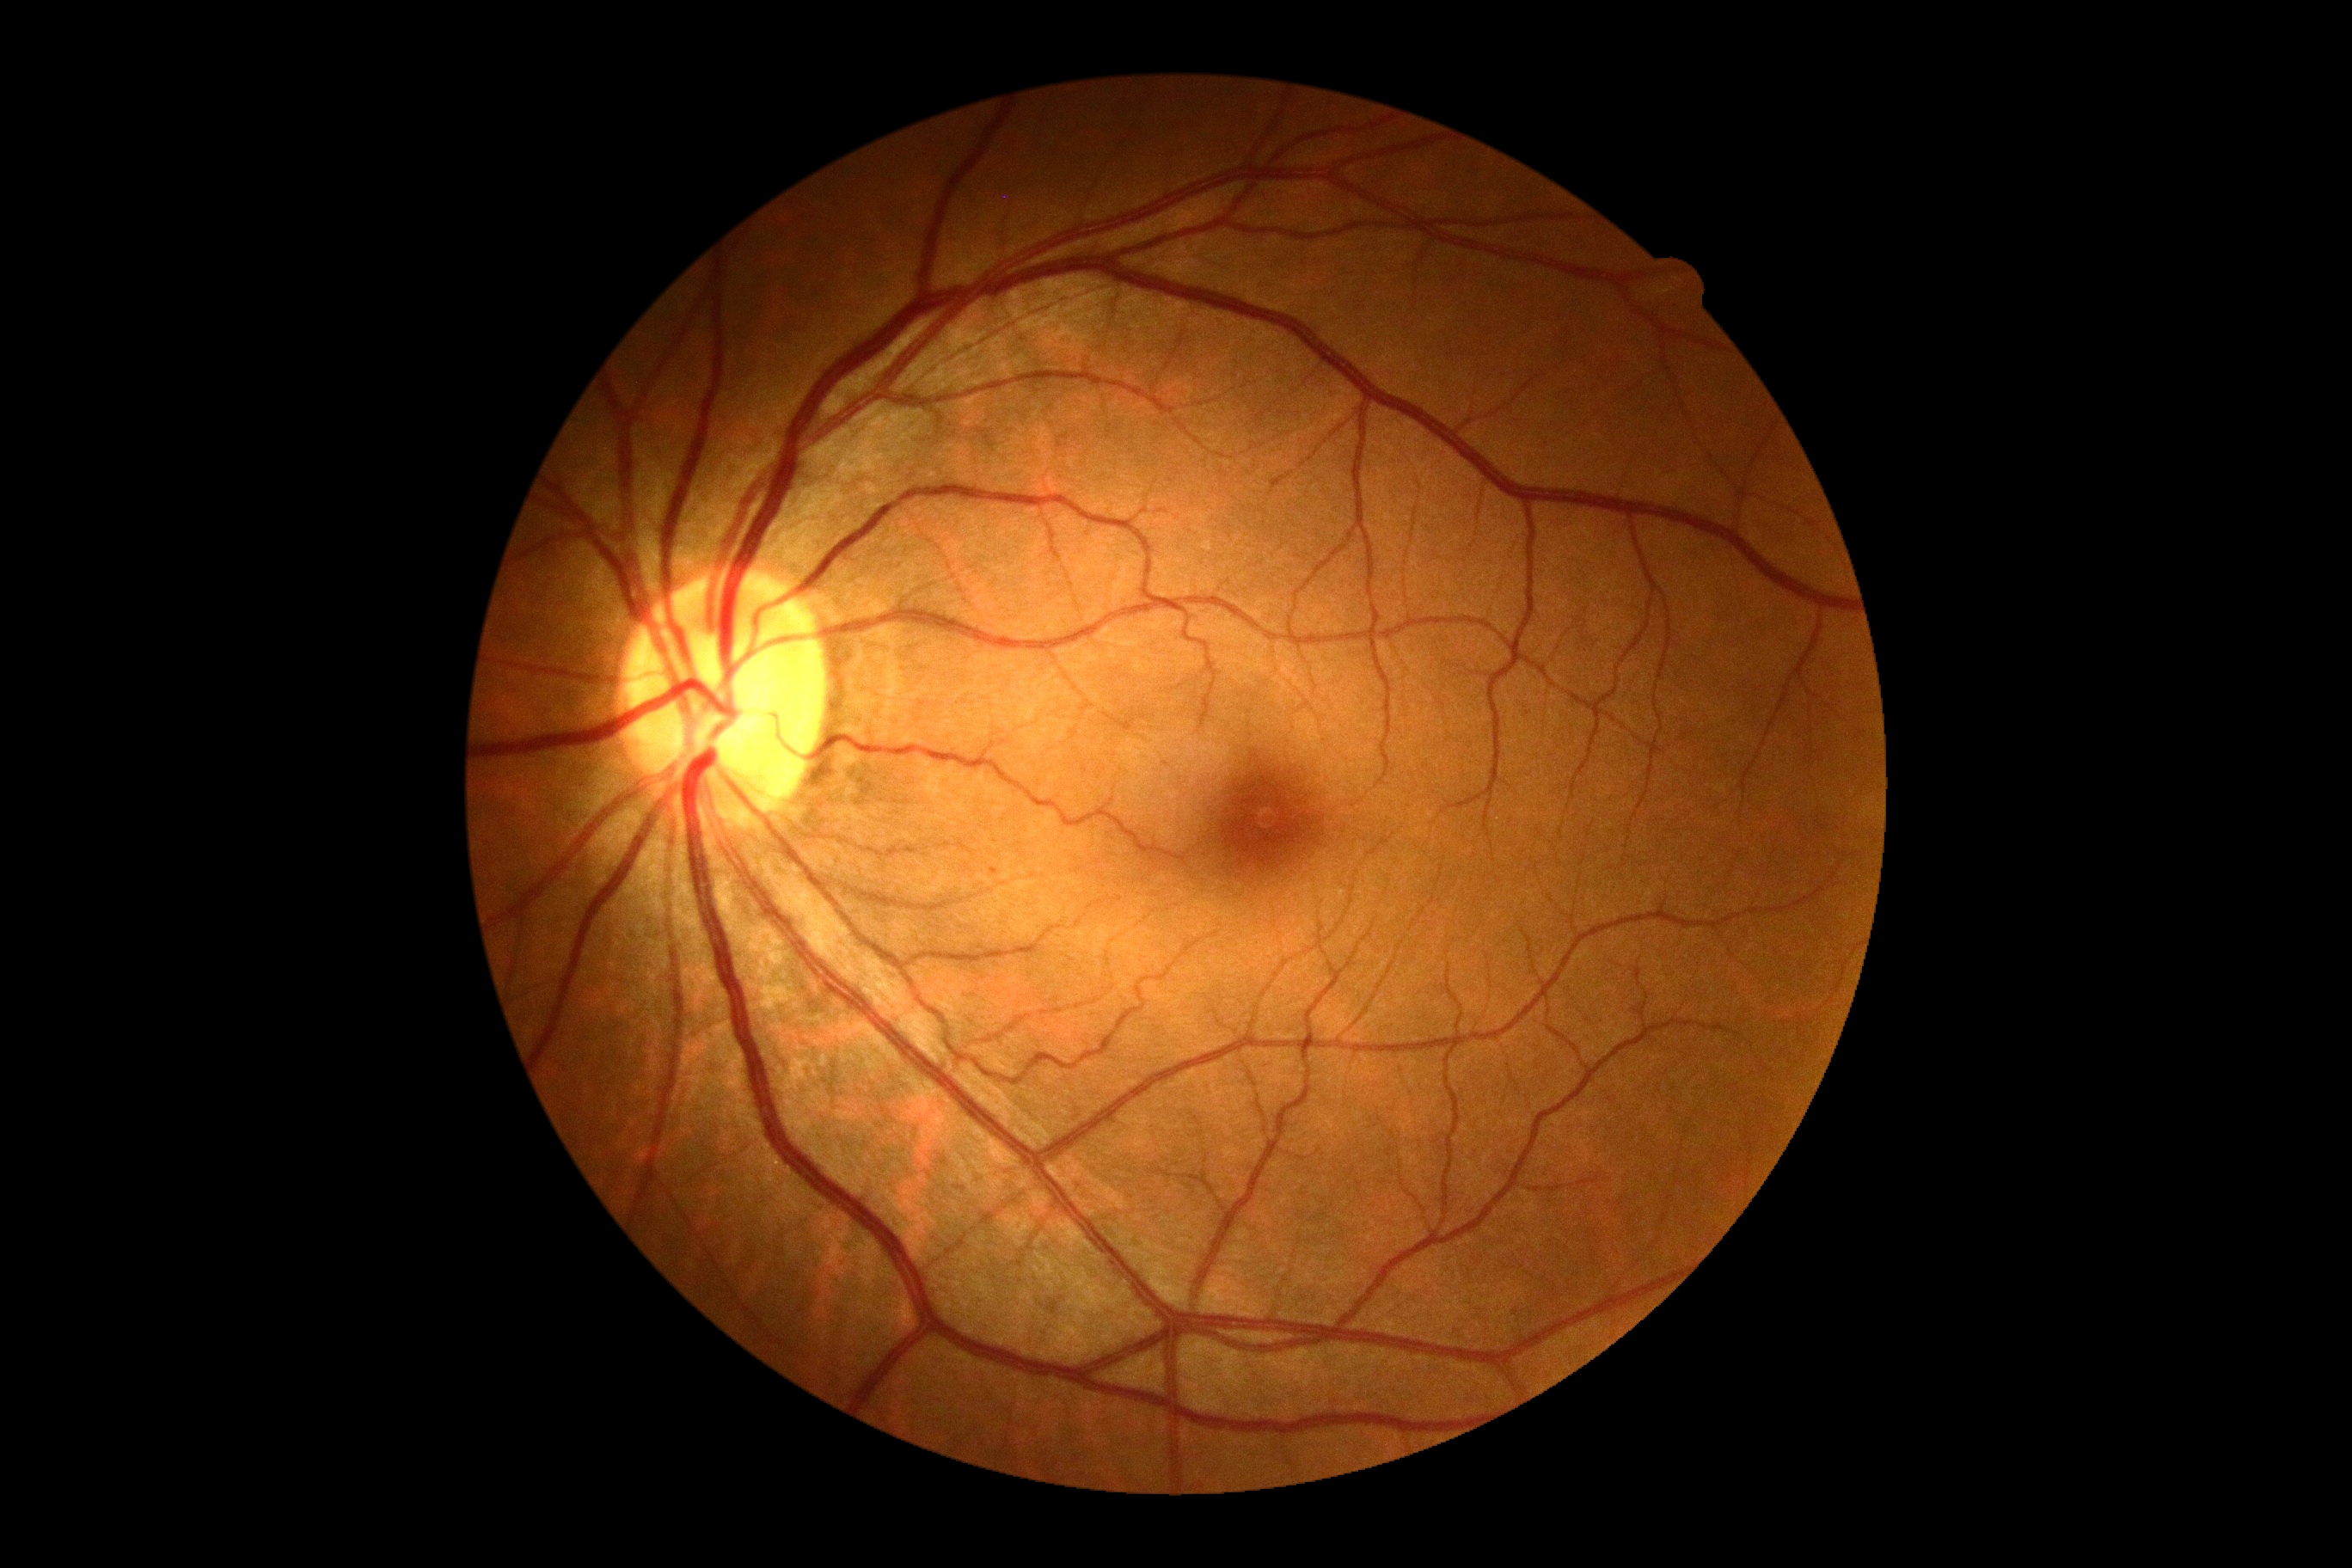

DR severity is no apparent retinopathy (grade 0) — no visible signs of diabetic retinopathy.